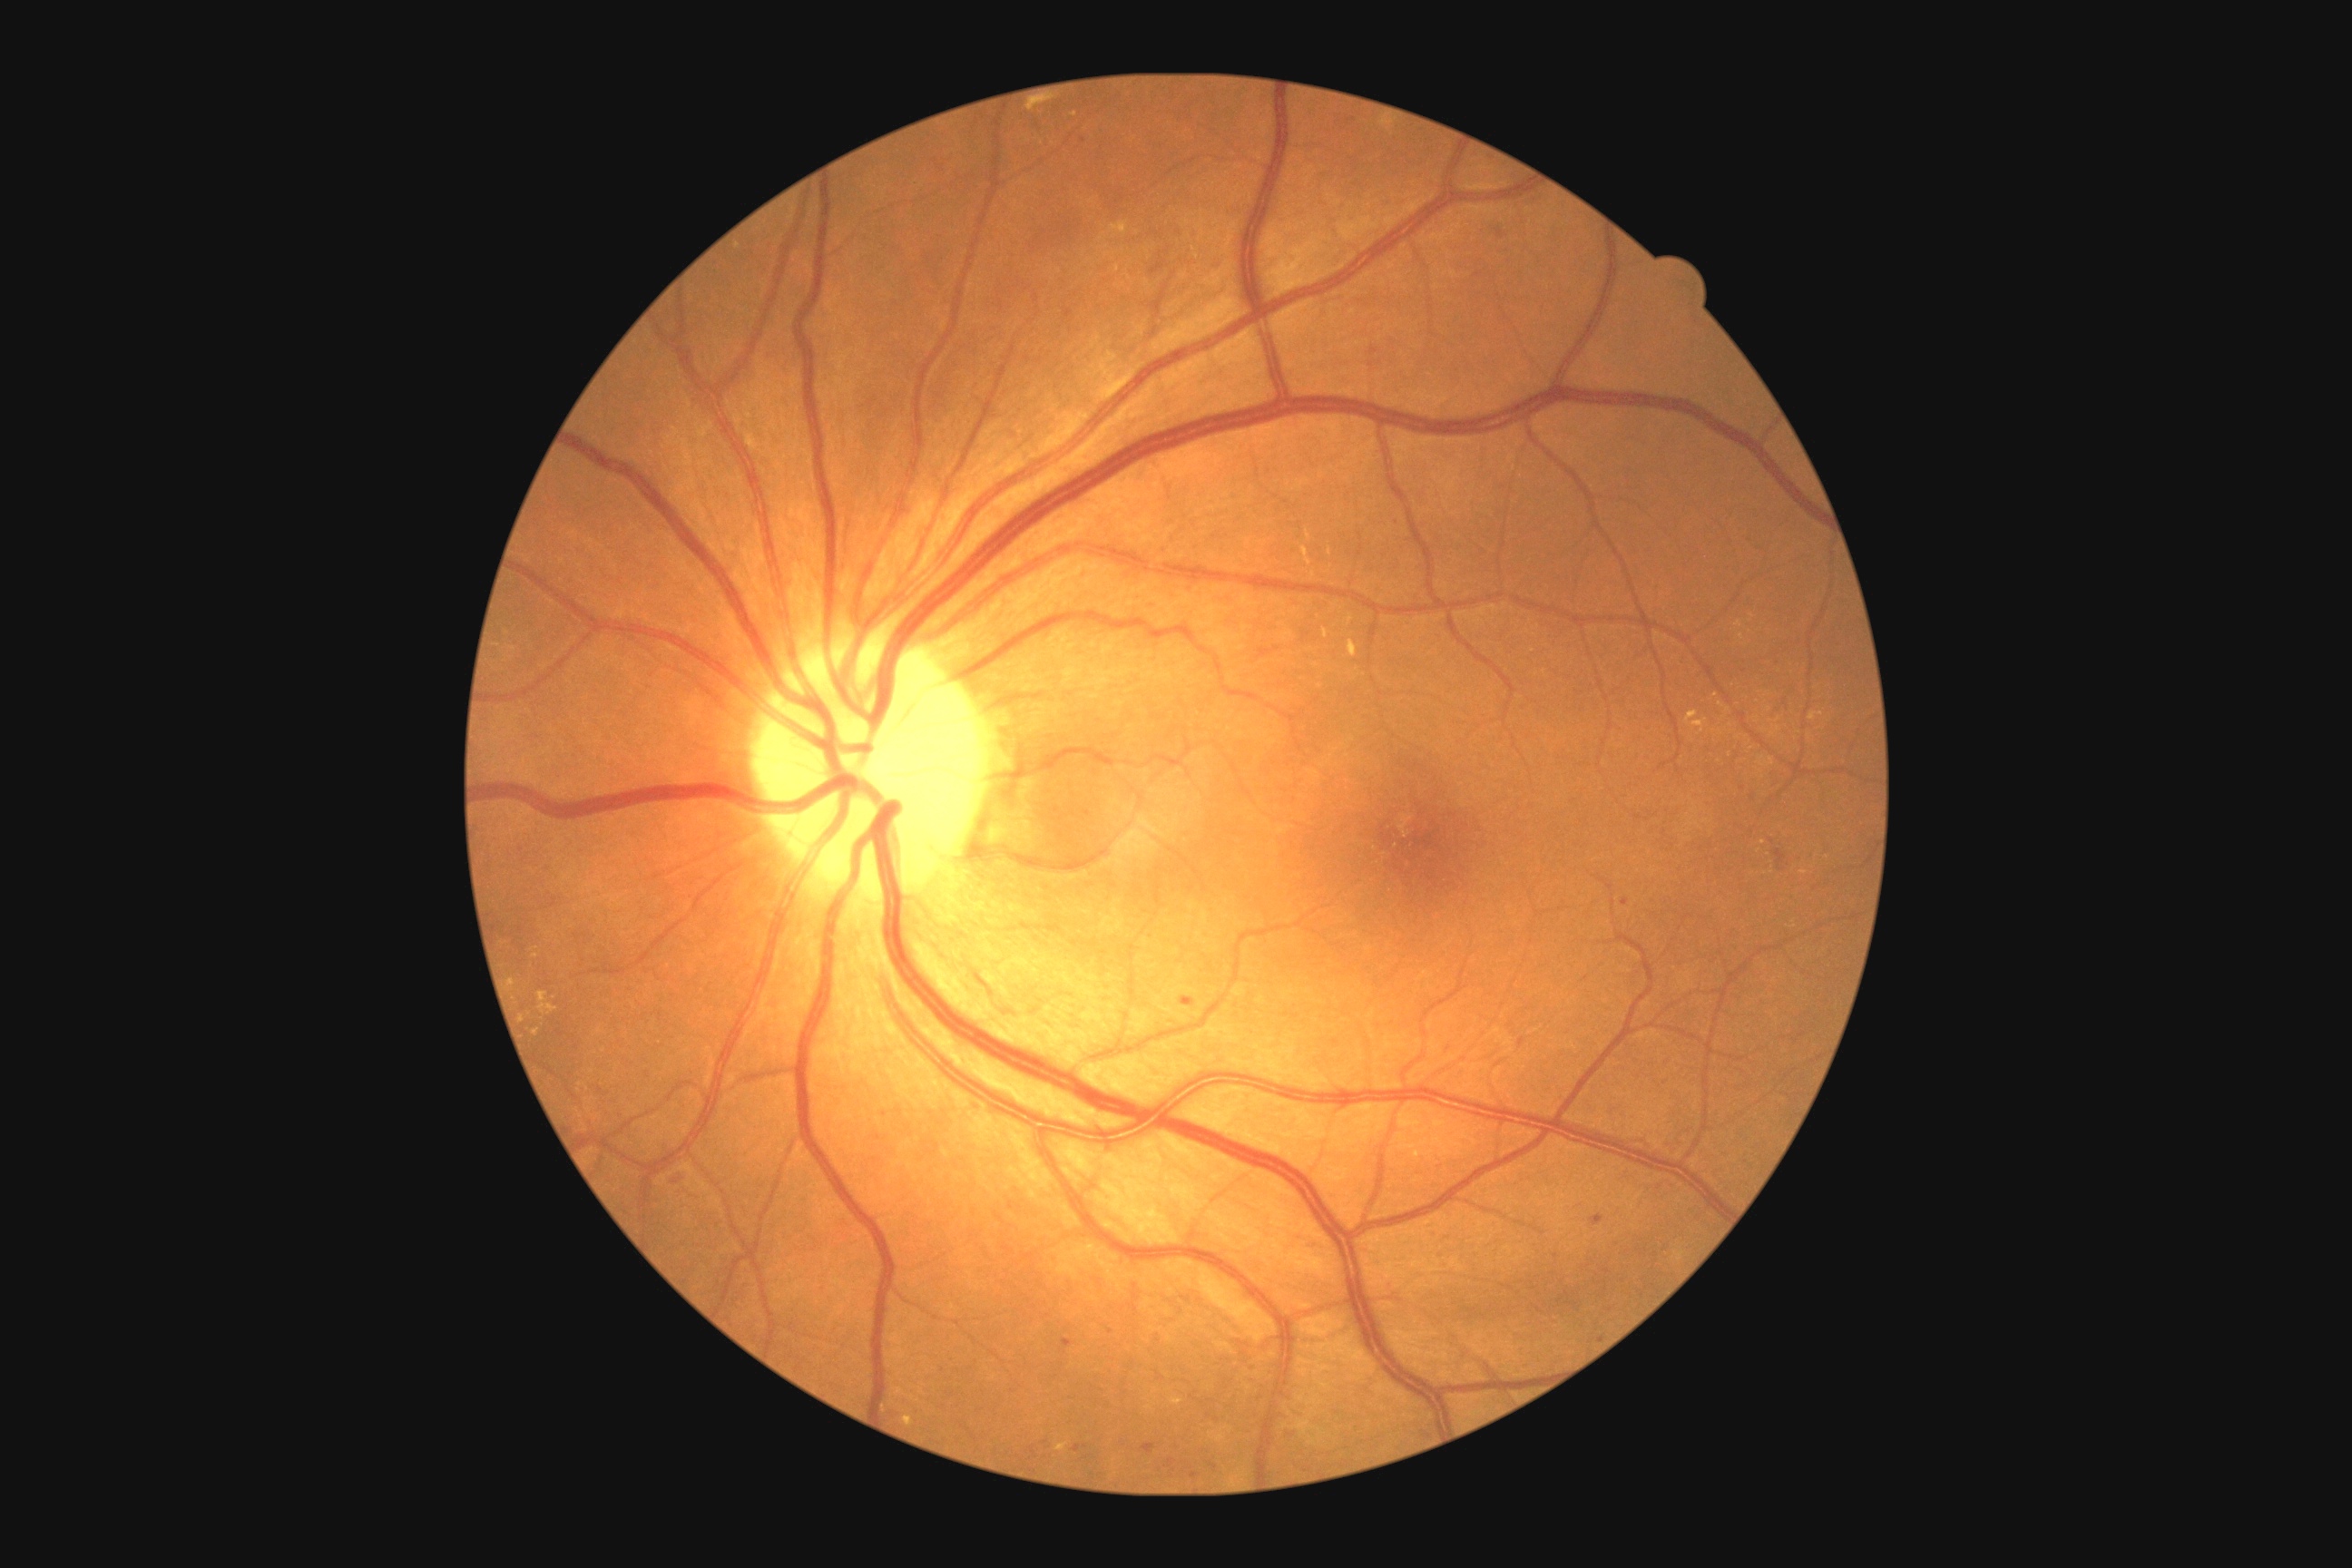 DR grade is 2/4
Selected lesions:
EXs (continued): region(520, 1015, 525, 1023) | region(1302, 547, 1313, 565) | region(1808, 712, 1823, 721) | region(1685, 710, 1709, 732) | region(1055, 1444, 1068, 1453) | region(1324, 629, 1329, 640) | region(1026, 101, 1048, 112) | region(1306, 531, 1311, 540) | region(1193, 248, 1200, 259)
Smaller EXs around 1722, 706 | 1828, 857 | 1759, 851 | 537, 956 | 1329, 552 | 738, 247 | 1752, 616 | 1118, 269
HEs: none detected
SEs: none detected
MAs (continued): region(1073, 1446, 1088, 1453) | region(1589, 1215, 1605, 1226) | region(1182, 997, 1195, 1006) | region(1400, 700, 1409, 707) | region(667, 1170, 689, 1188) | region(1498, 231, 1505, 239) | region(1369, 346, 1380, 357) | region(1063, 1340, 1073, 1348)
Smaller MAs around 1556, 1257 | 1371, 366 | 1351, 120 | 1773, 841